Modified Davis grading · retinal fundus photograph:
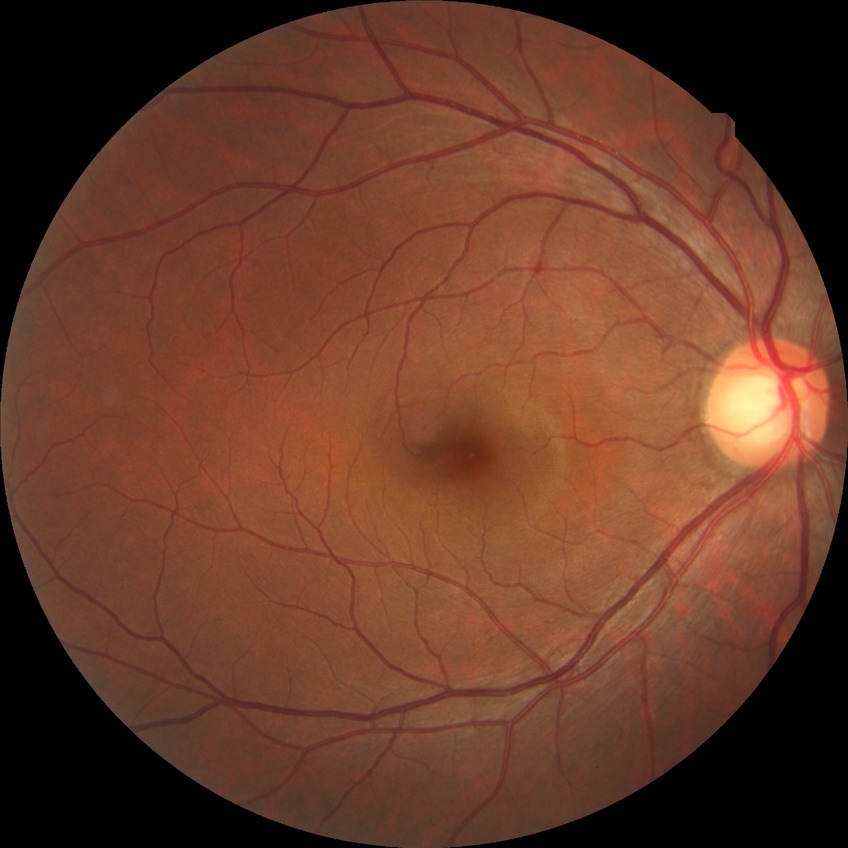

Diabetic retinopathy (DR): NDR (no diabetic retinopathy).